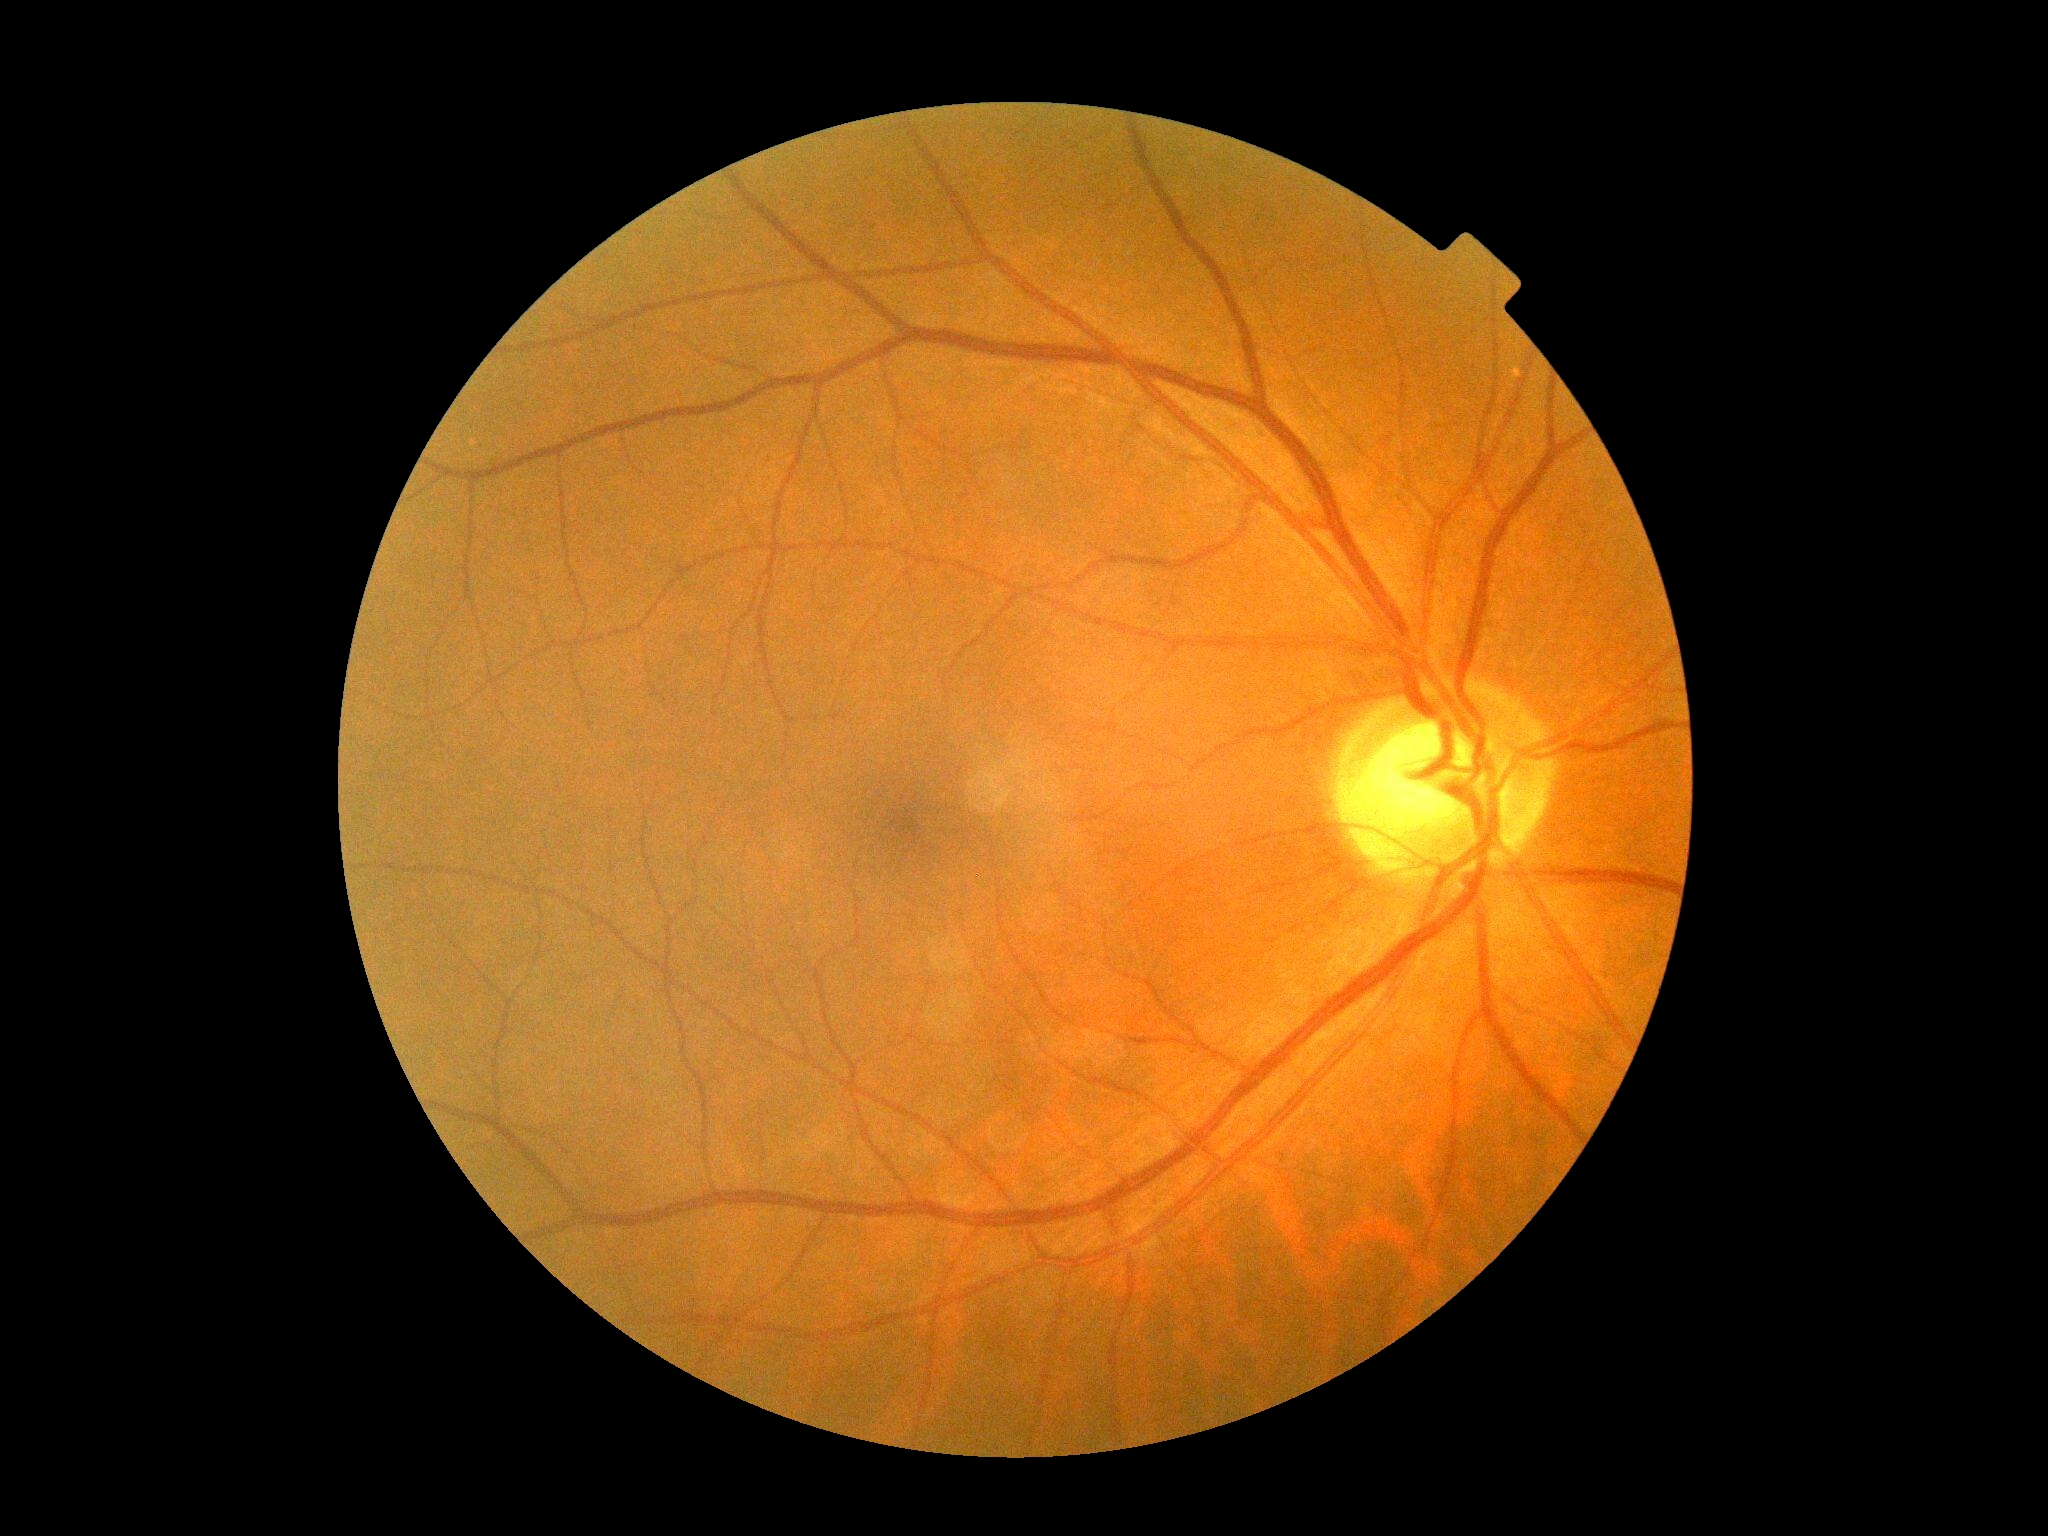
Findings:
* diabetic retinopathy (DR): grade 0